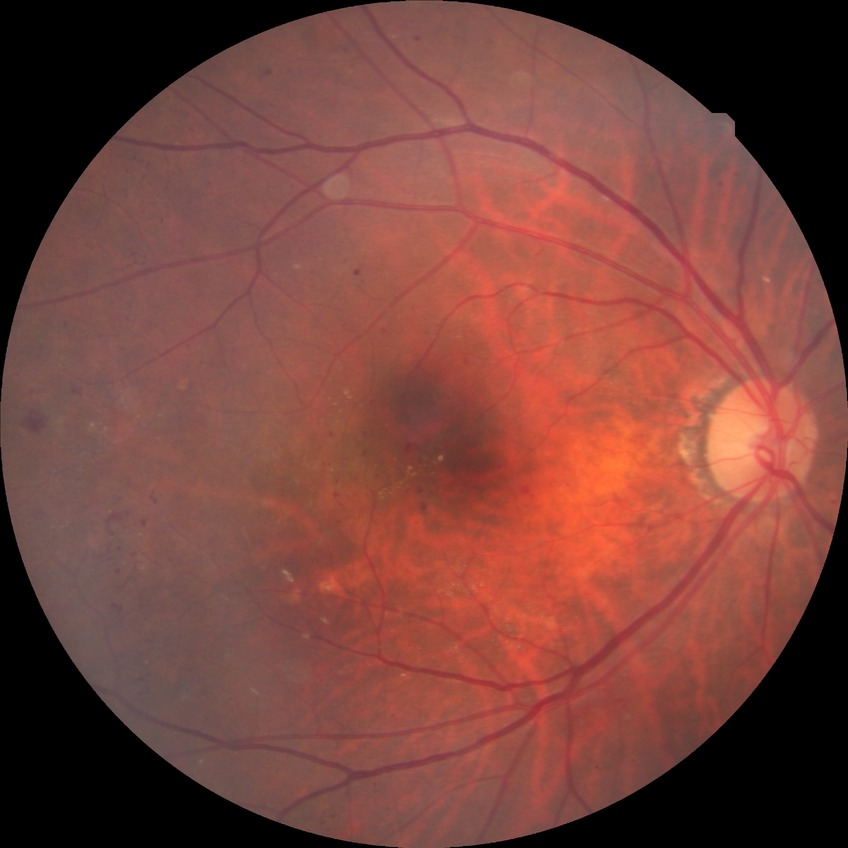
retinopathy grade: proliferative diabetic retinopathy.